Camera: NIDEK AFC-230.
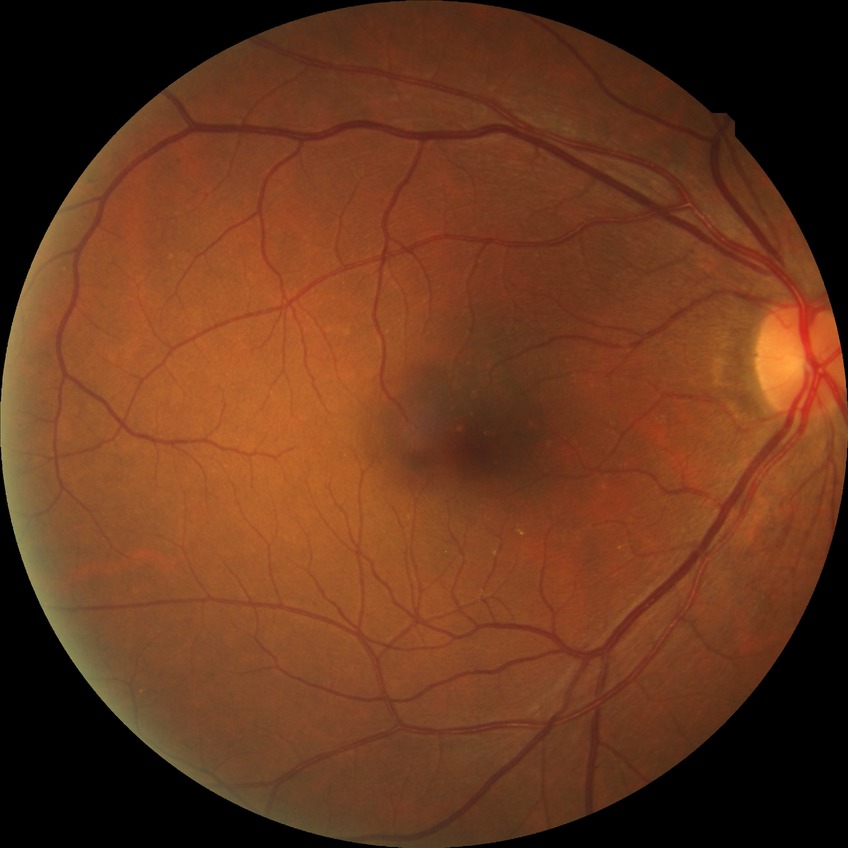 {"davis_grade": "NDR"}